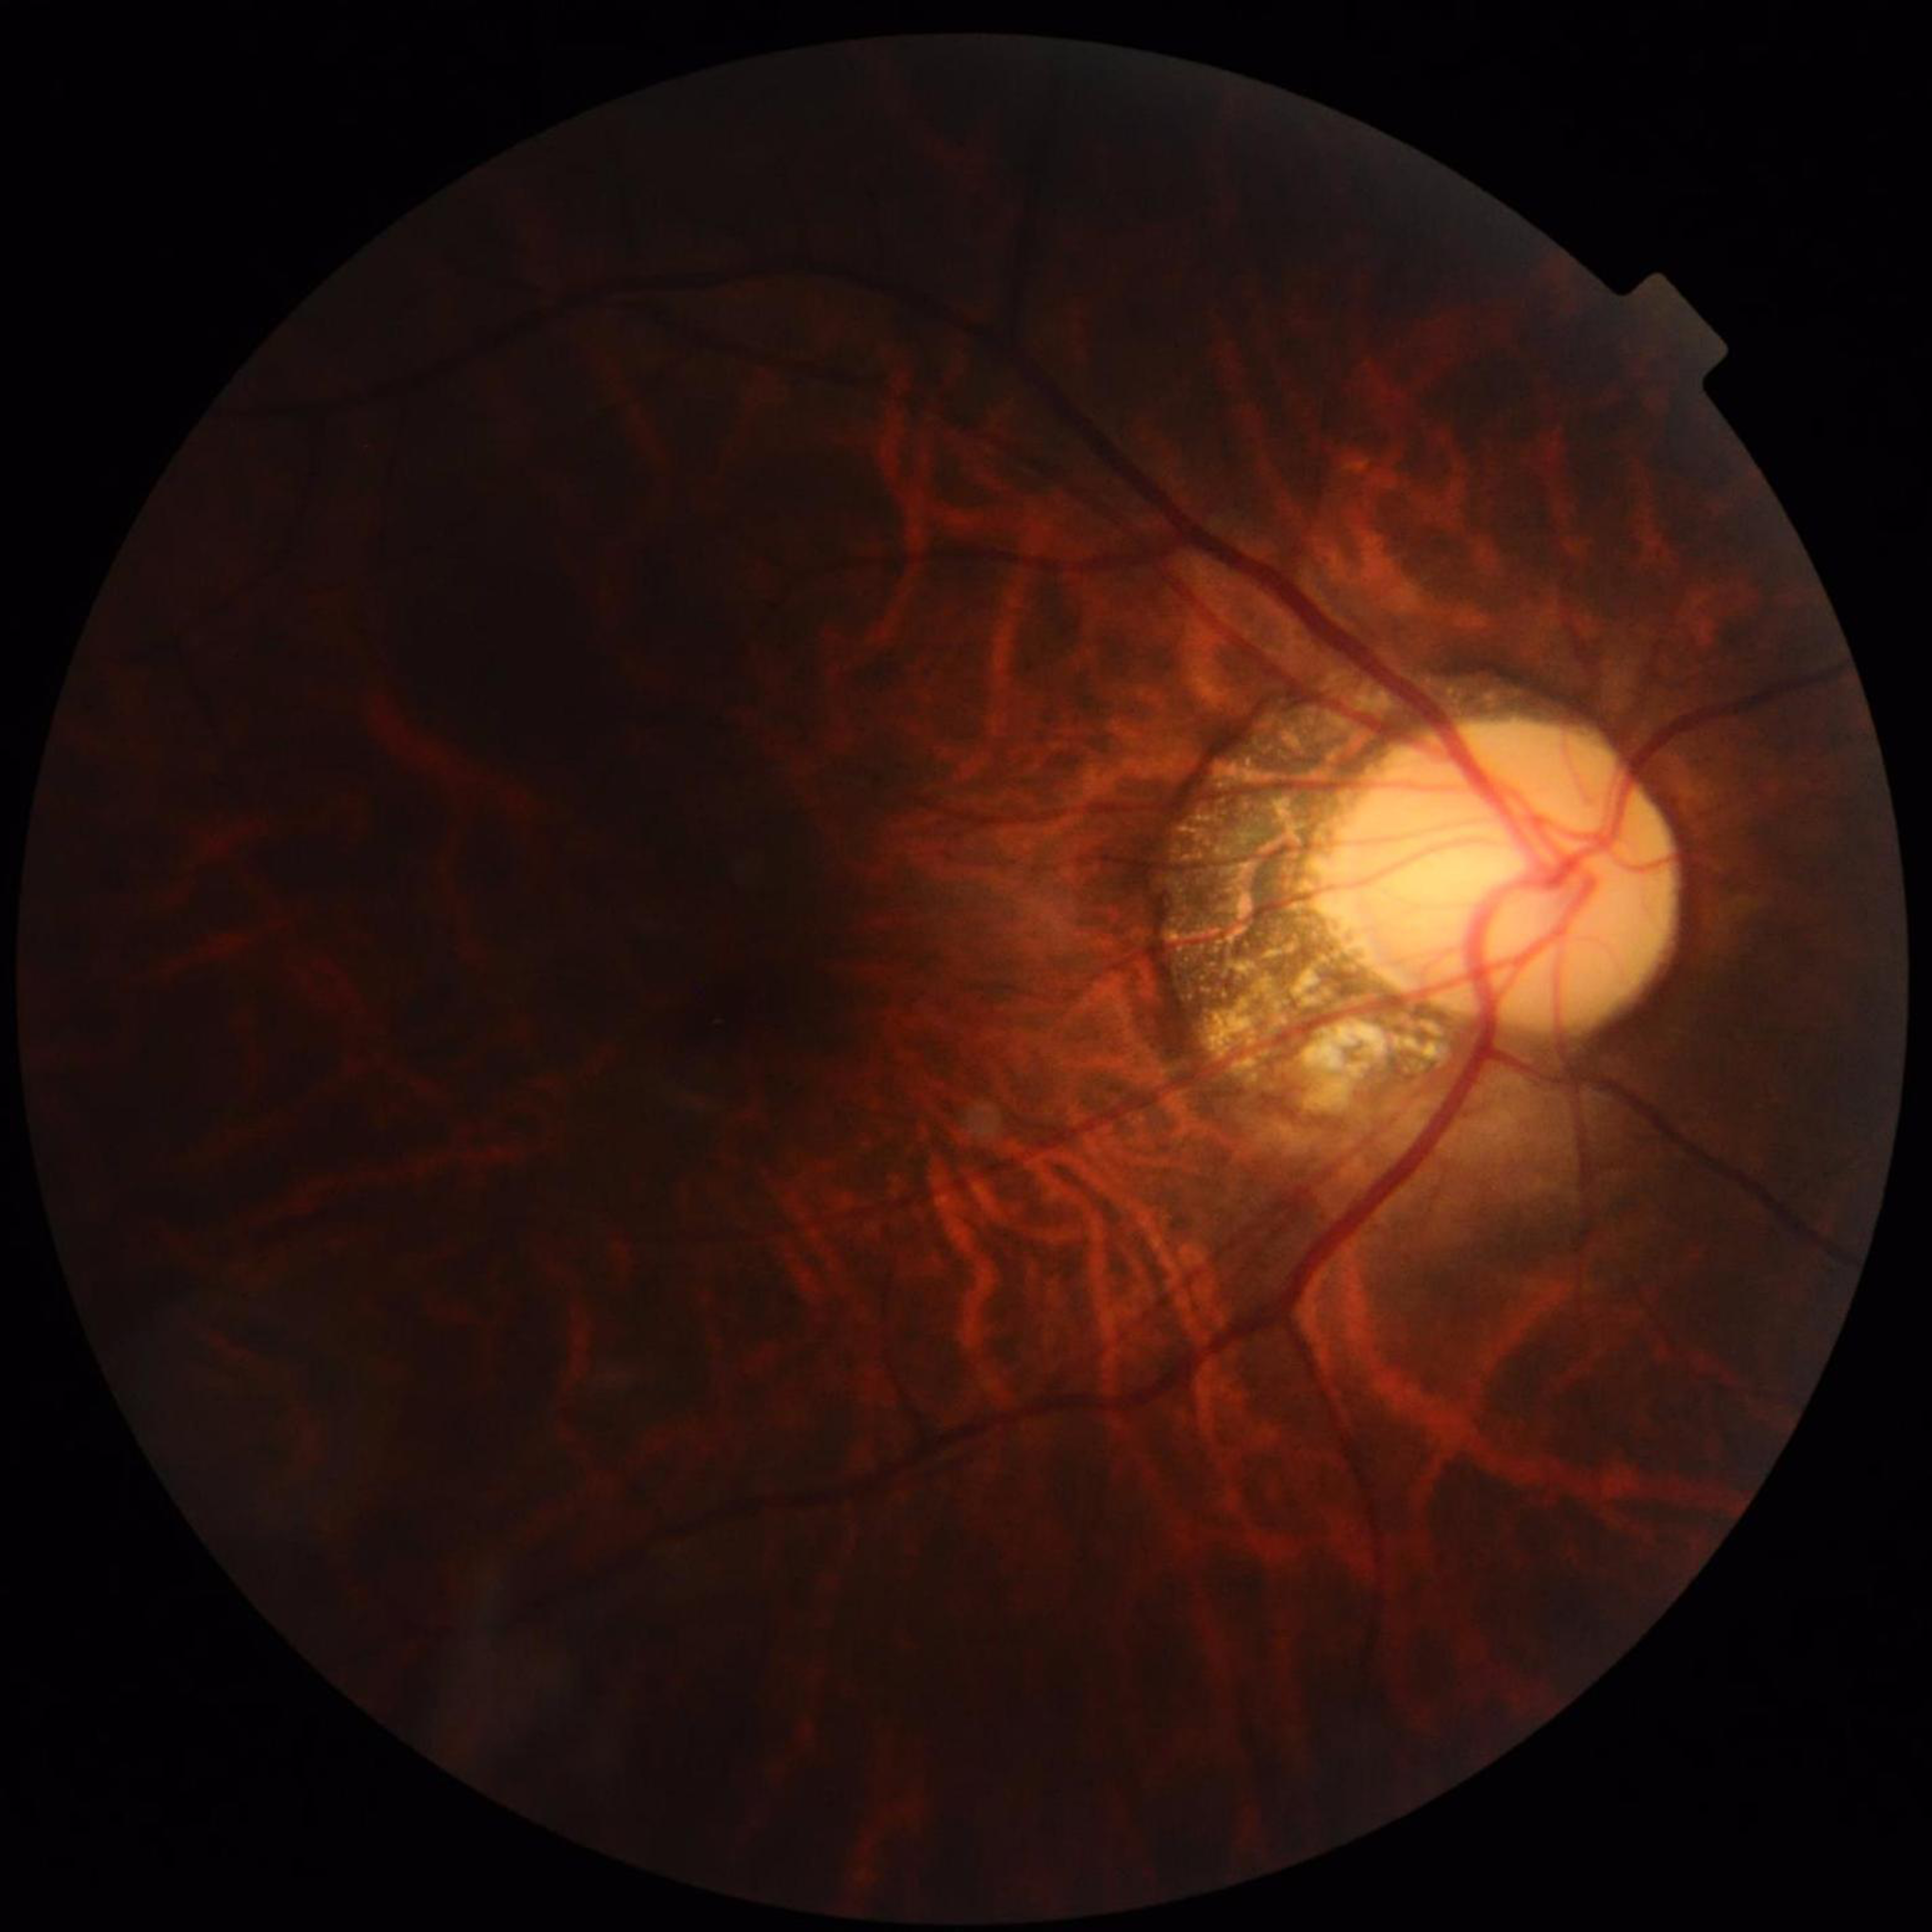

Automated quality assessment: suboptimal — illumination/color distortion, blur.
Retinal fundus photograph from a patient with glaucoma.